Acquired with a Remidio Fundus on Phone (FOP) camera · 1659 x 2212 pixels · color fundus photograph:
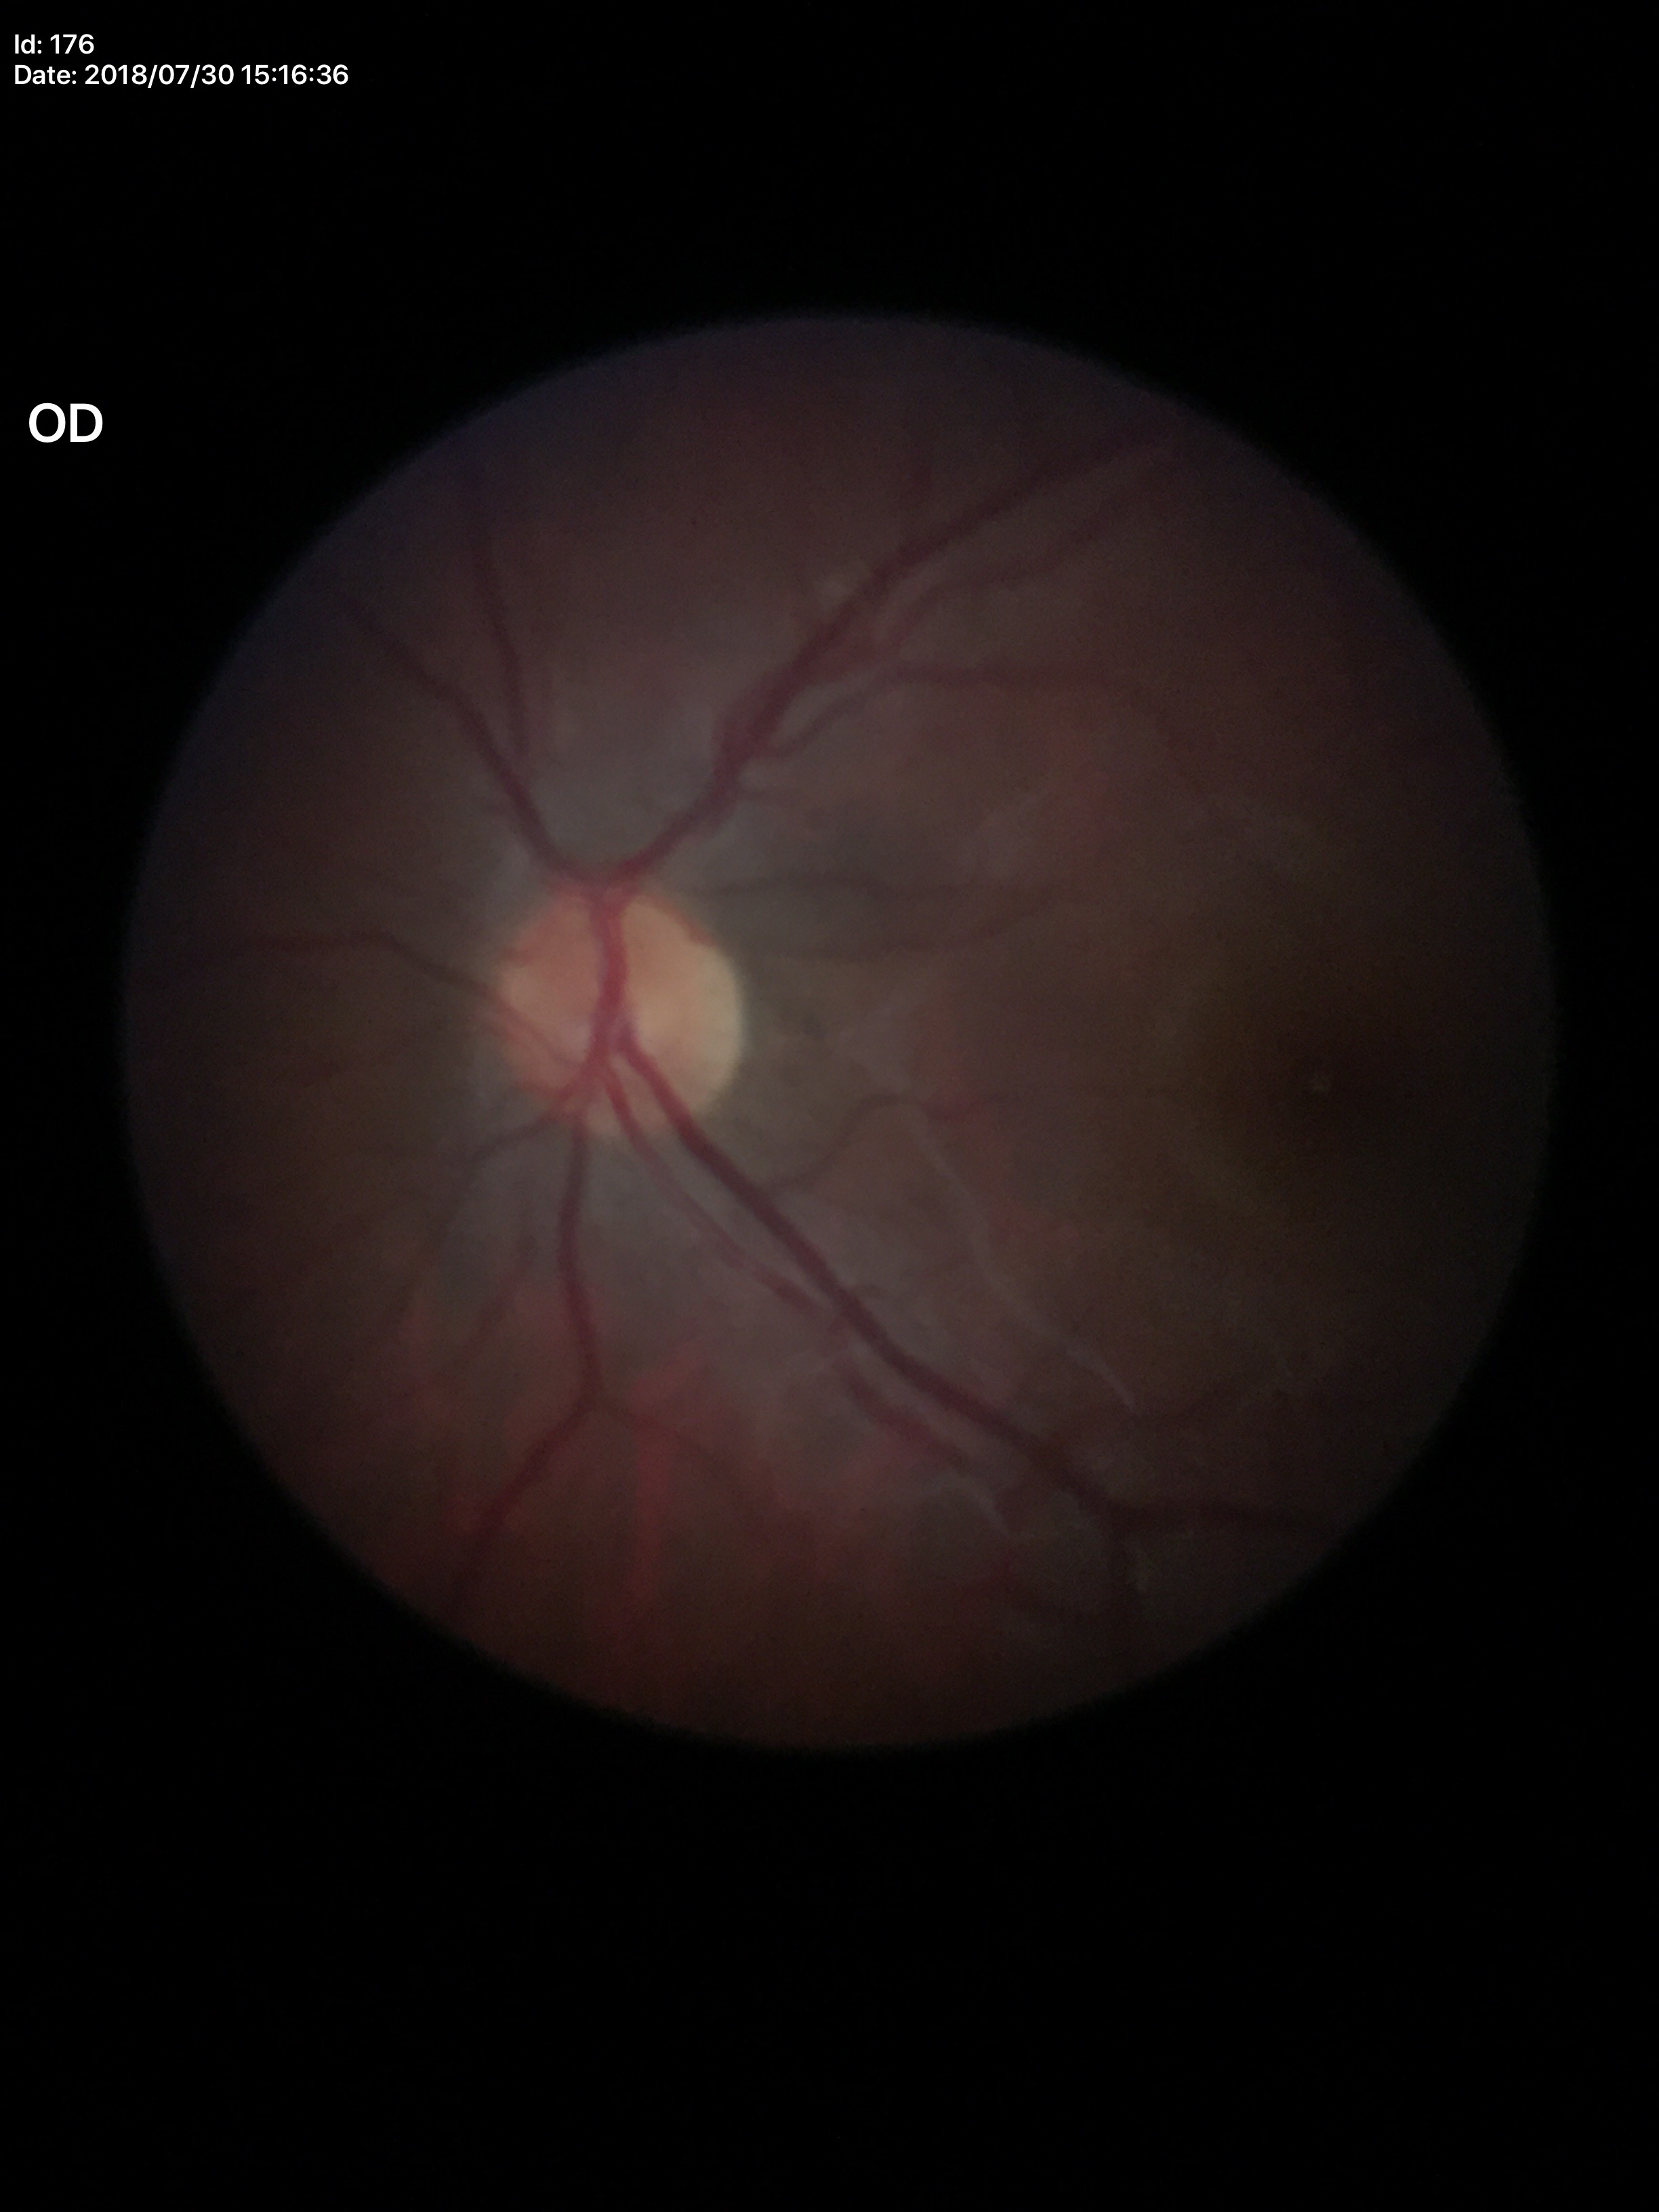
Glaucoma evaluation: no suspicious findings. VCDR is 0.43.